45° FOV. Color fundus image. 1932 x 1932 pixels — 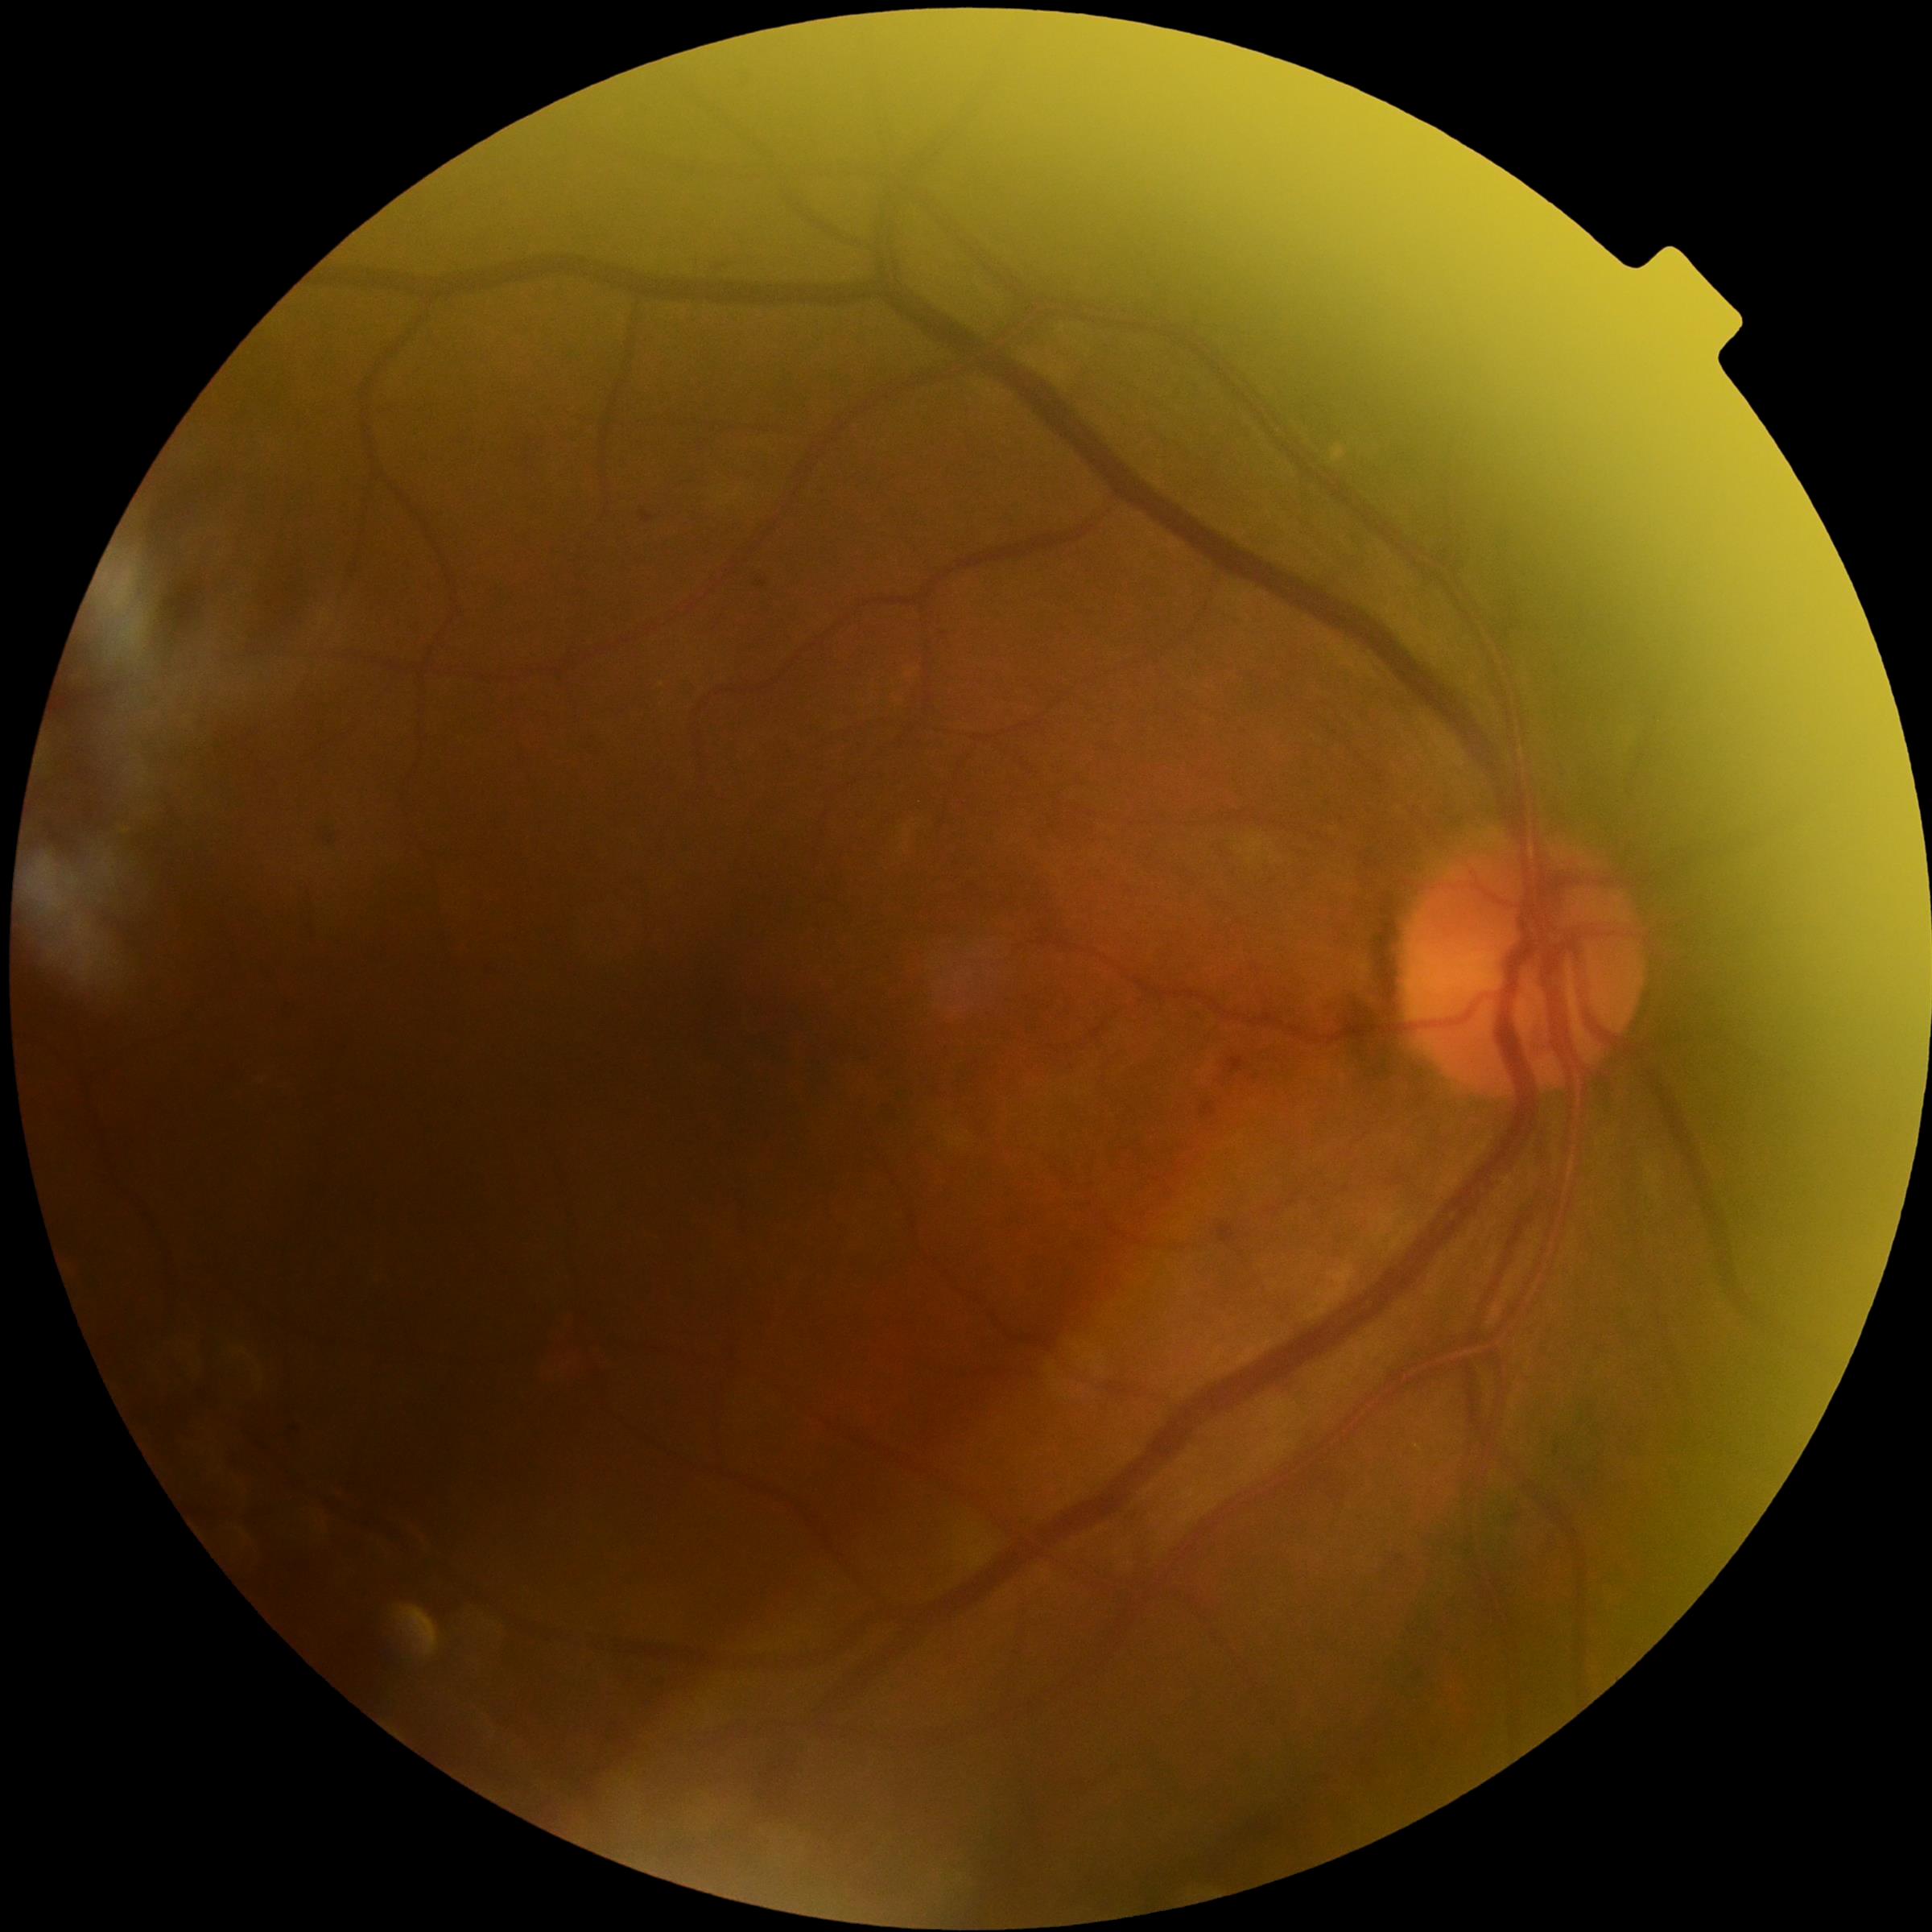

DR: moderate NPDR (grade 2).